Color fundus image:
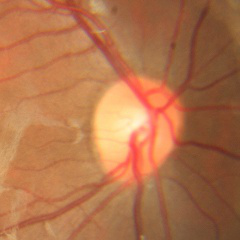
No glaucoma.